640x480. Wide-field fundus photograph of an infant:
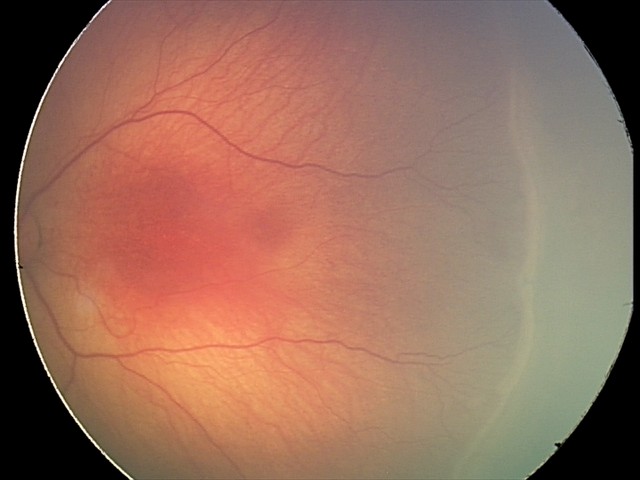 Screening diagnosis: no plus disease | ROP stage 2 — ridge with height and width at the demarcation line.